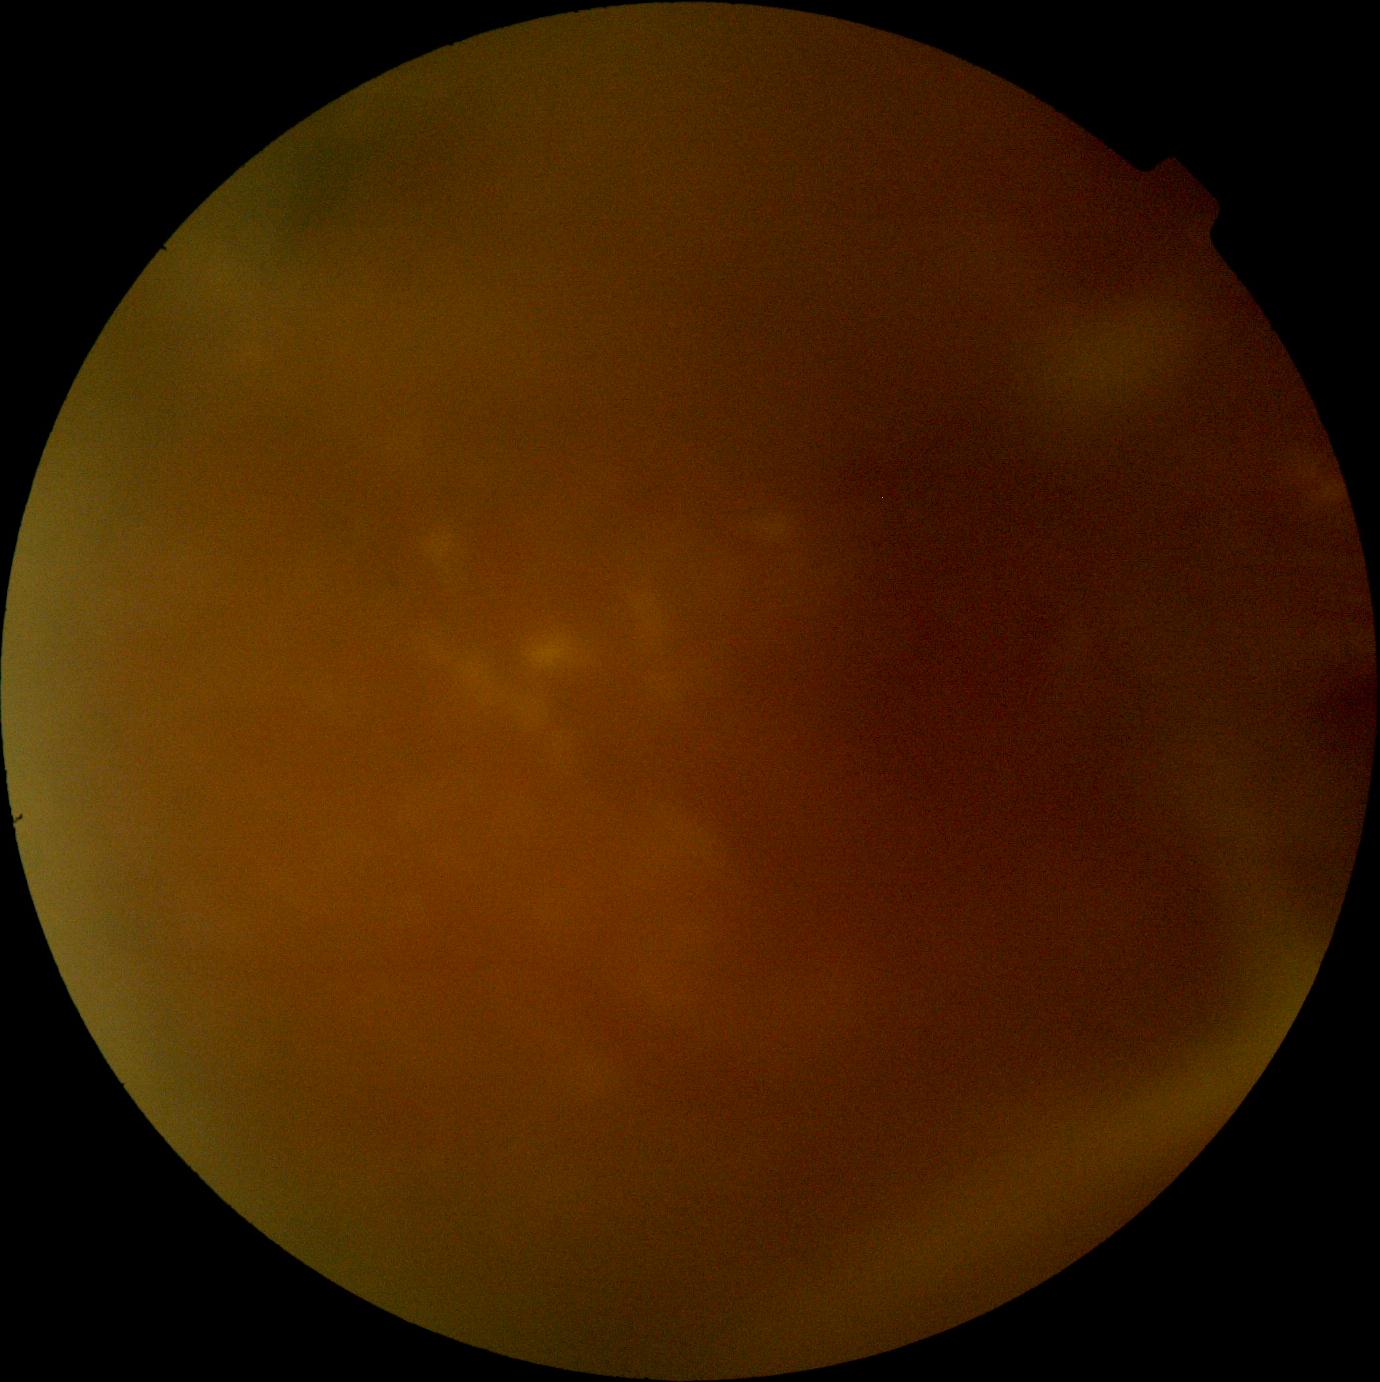
DR severity: ungradable due to poor image quality.